FOV: 45 degrees. 2048 x 1536 pixels. Retinal fundus photograph:
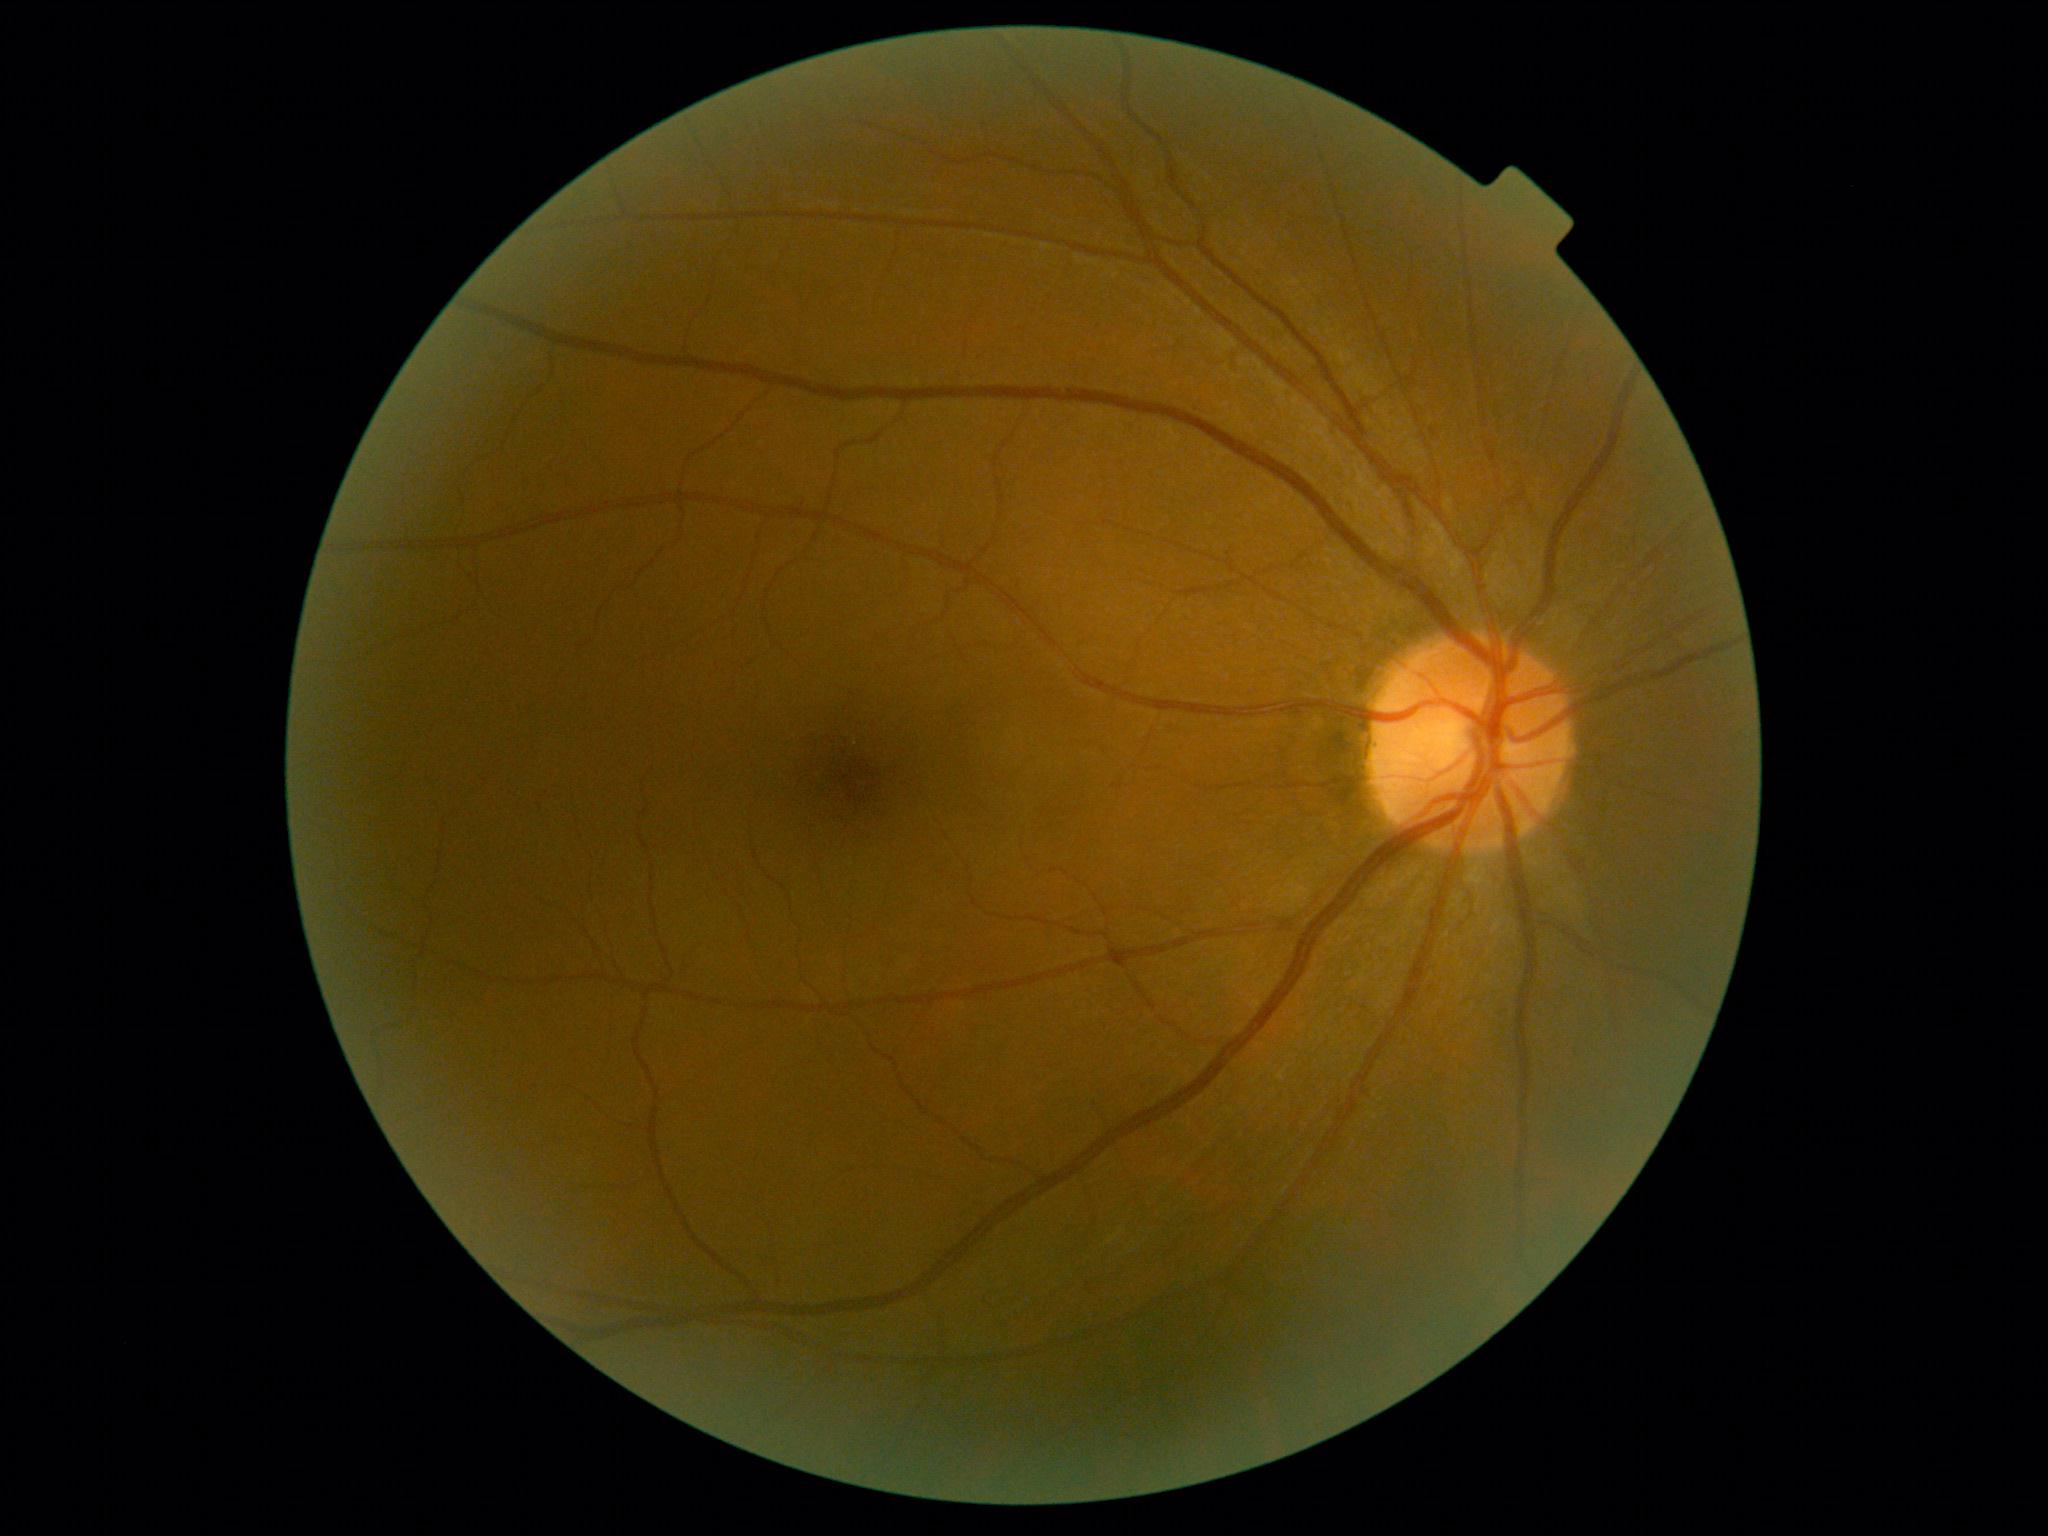

DR class: non-proliferative diabetic retinopathy.
Retinopathy grade: 1 — presence of microaneurysms only.